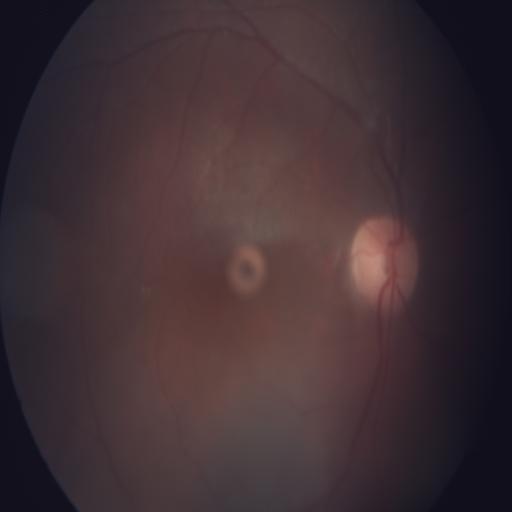

Diagnoses: media haze; hemorrhagic retinopathy.